45-degree field of view, color fundus photograph.
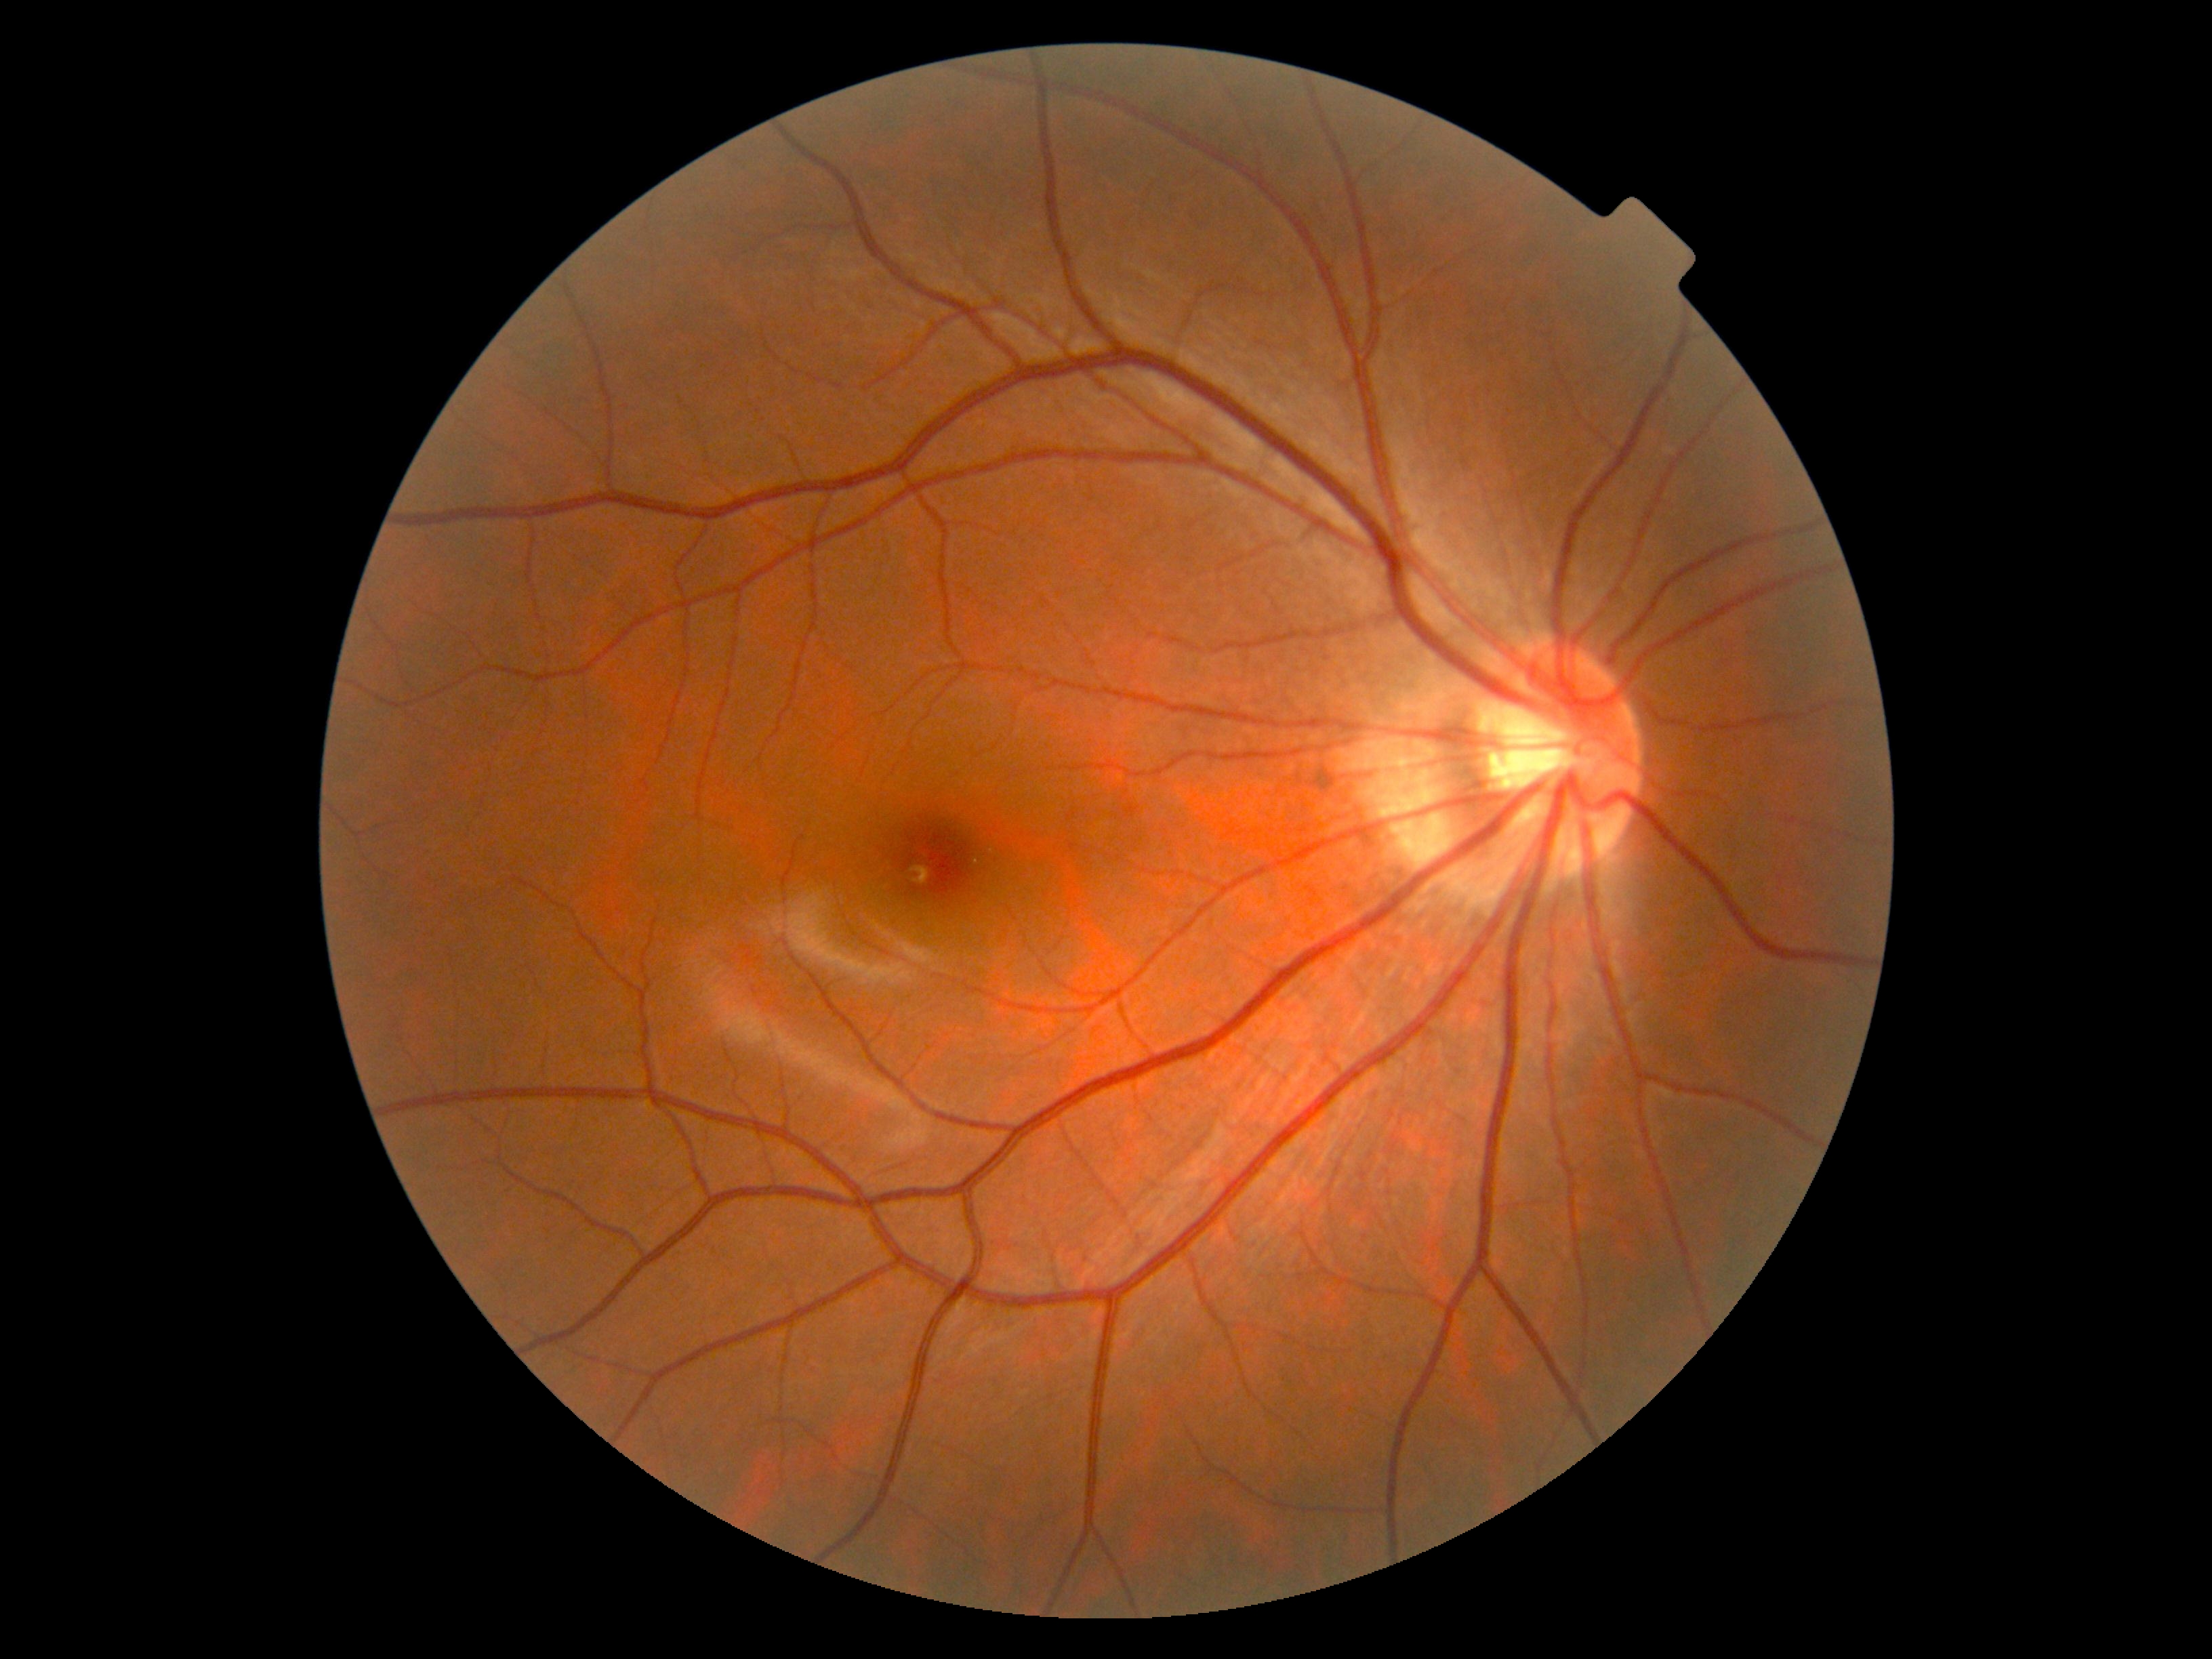
diabetic retinopathy = grade 0
DR impression = no apparent DR